45° field of view; 2212x1659; color fundus image
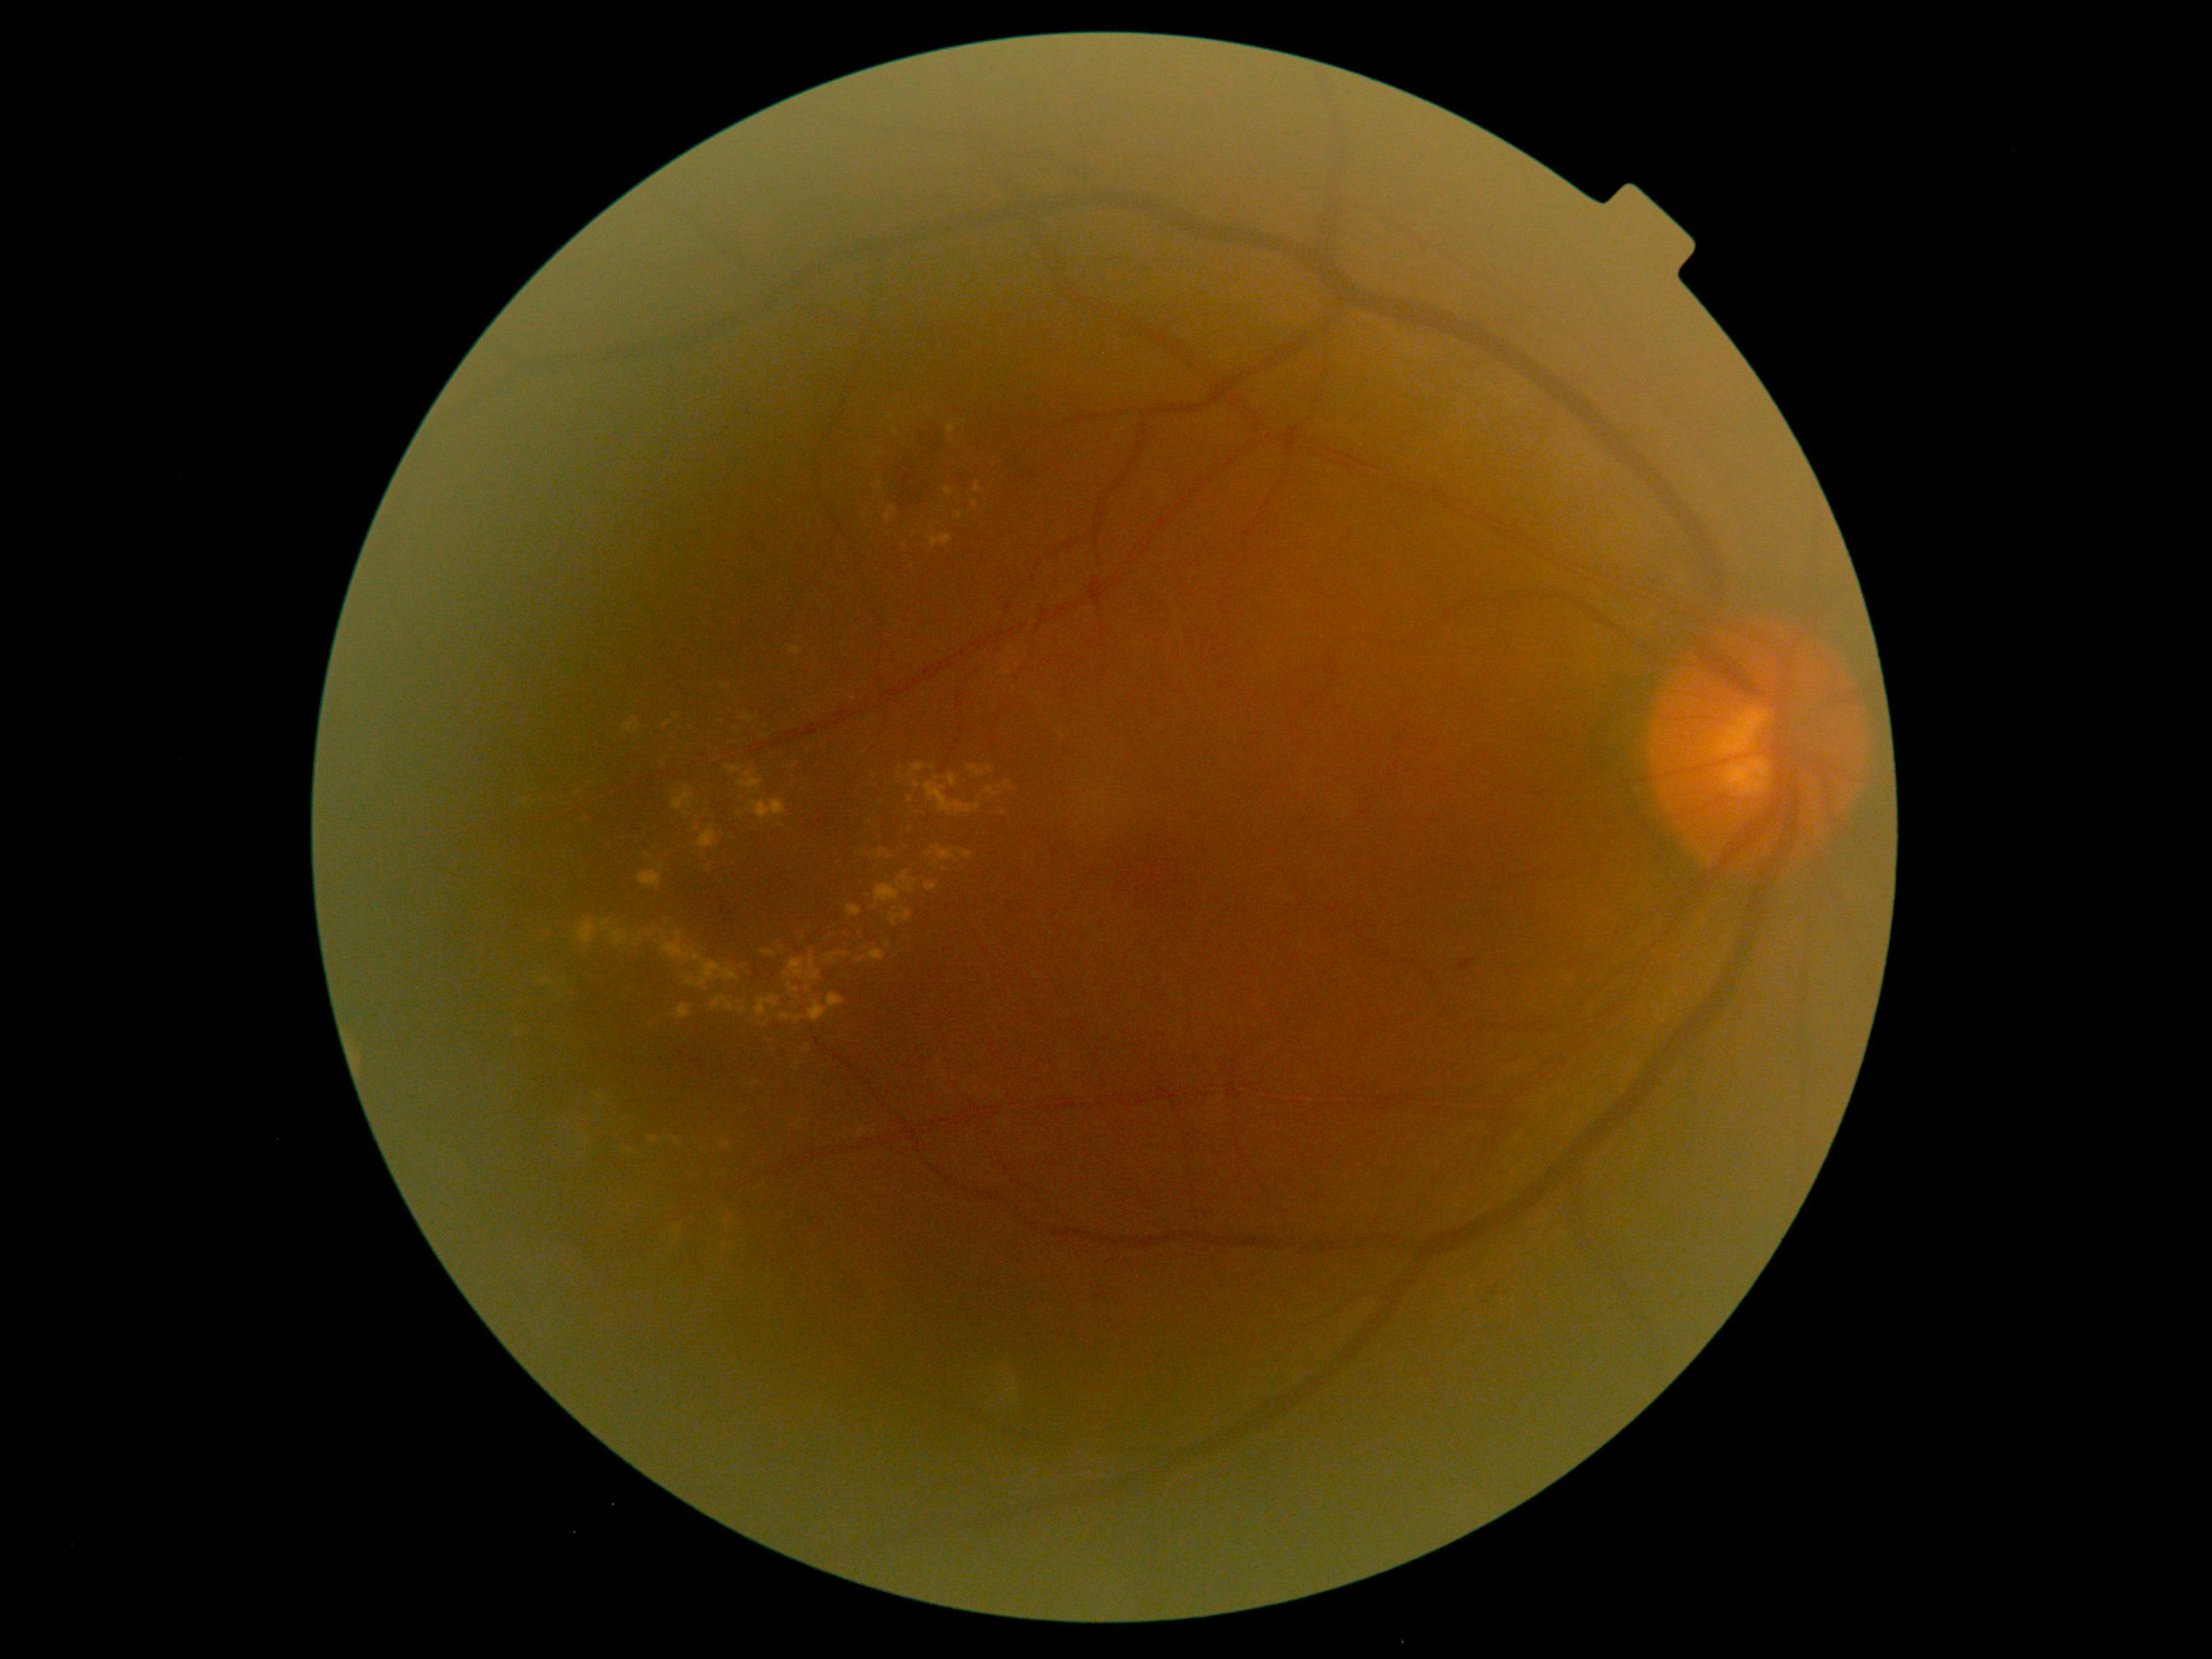

  dr_grade: moderate NPDR (grade 2)